Diabetic retinopathy graded by the modified Davis classification
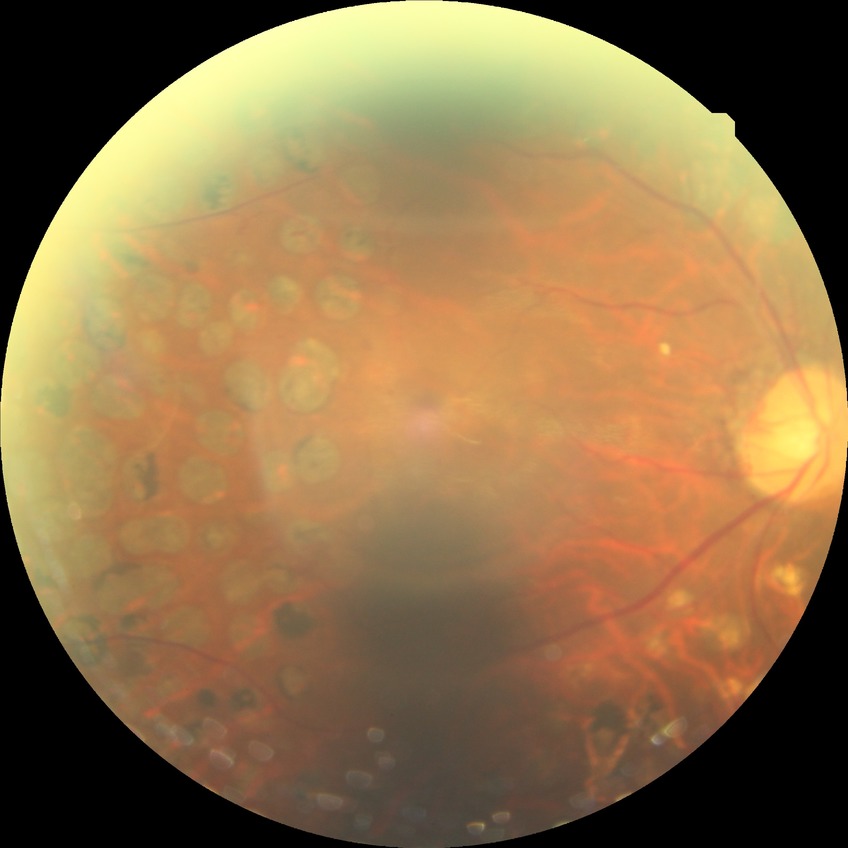

Diabetic retinopathy (DR): proliferative diabetic retinopathy (PDR).